Dilated-pupil acquisition — 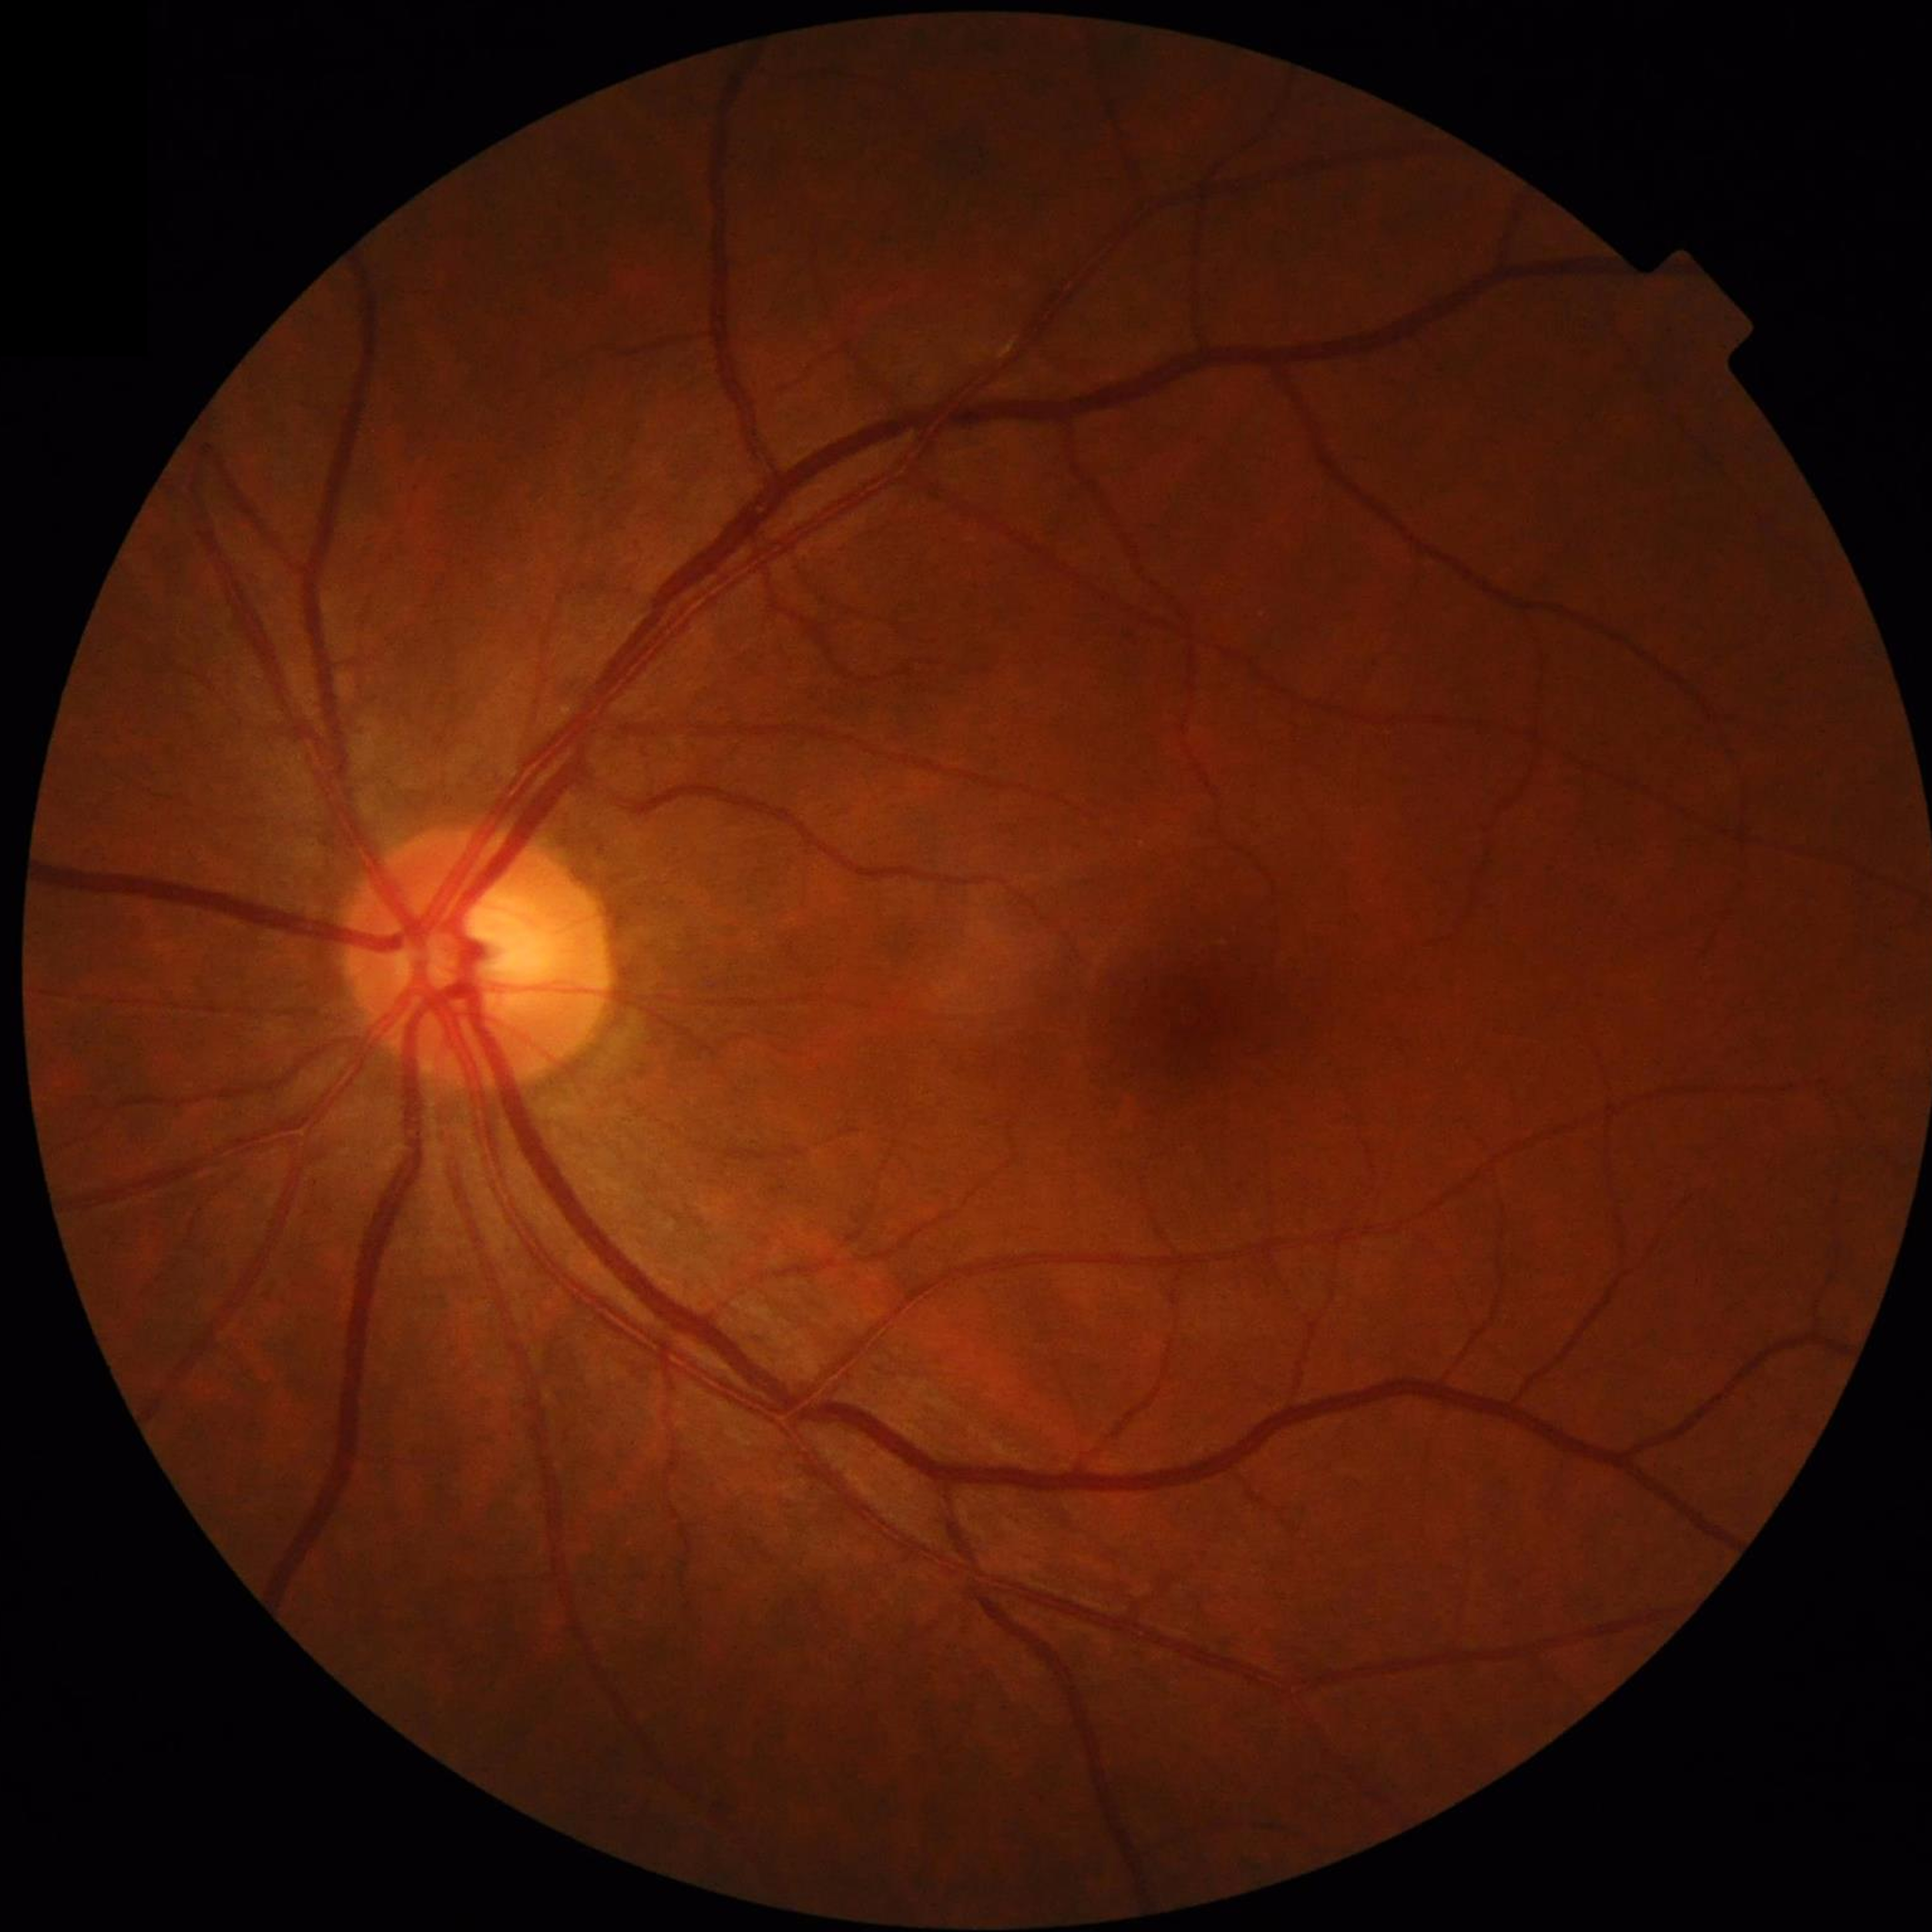
Diagnosis = control (no AMD/DR/glaucoma).